1932 by 1910 pixels — 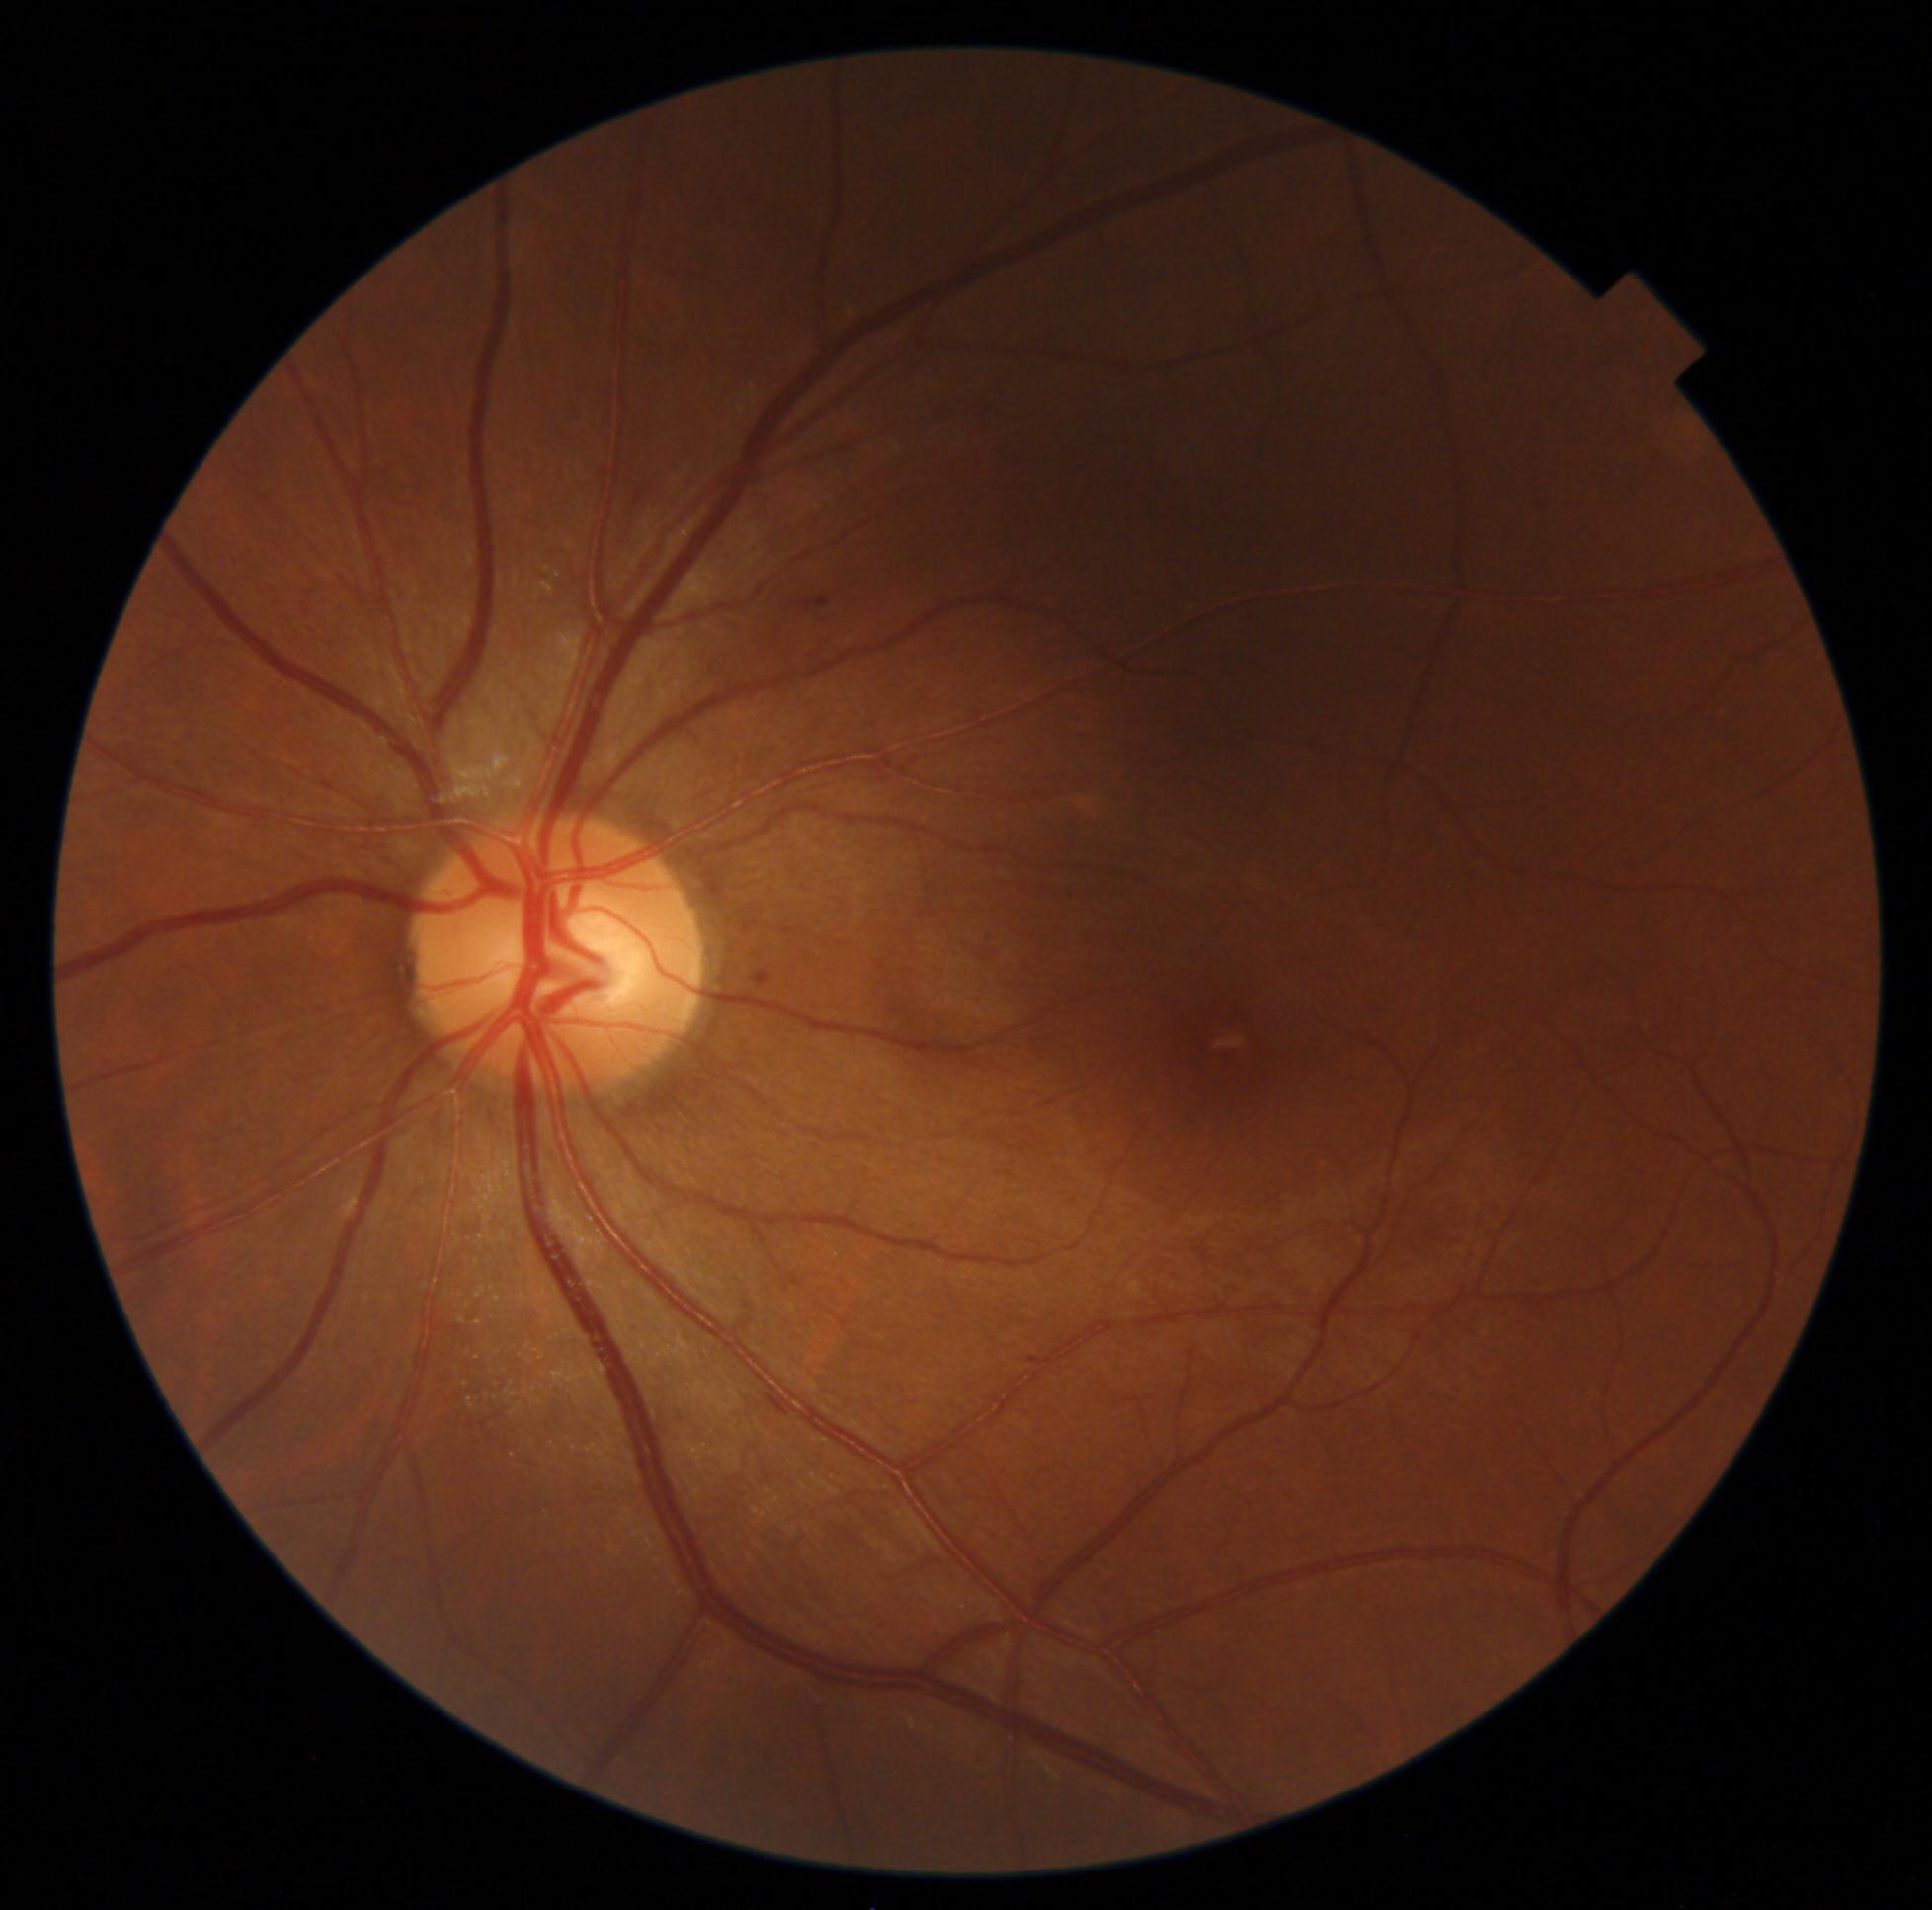

Retinopathy grade: 1
Detected lesions:
• hemorrhages: none identified
• soft exudates: none identified
• microaneurysms: 752,971,765,979; 822,599,833,606; 1027,1353,1034,1364
• hard exudates: none identified